FOV: 45 degrees, 2212x1672, retinal fundus photograph: 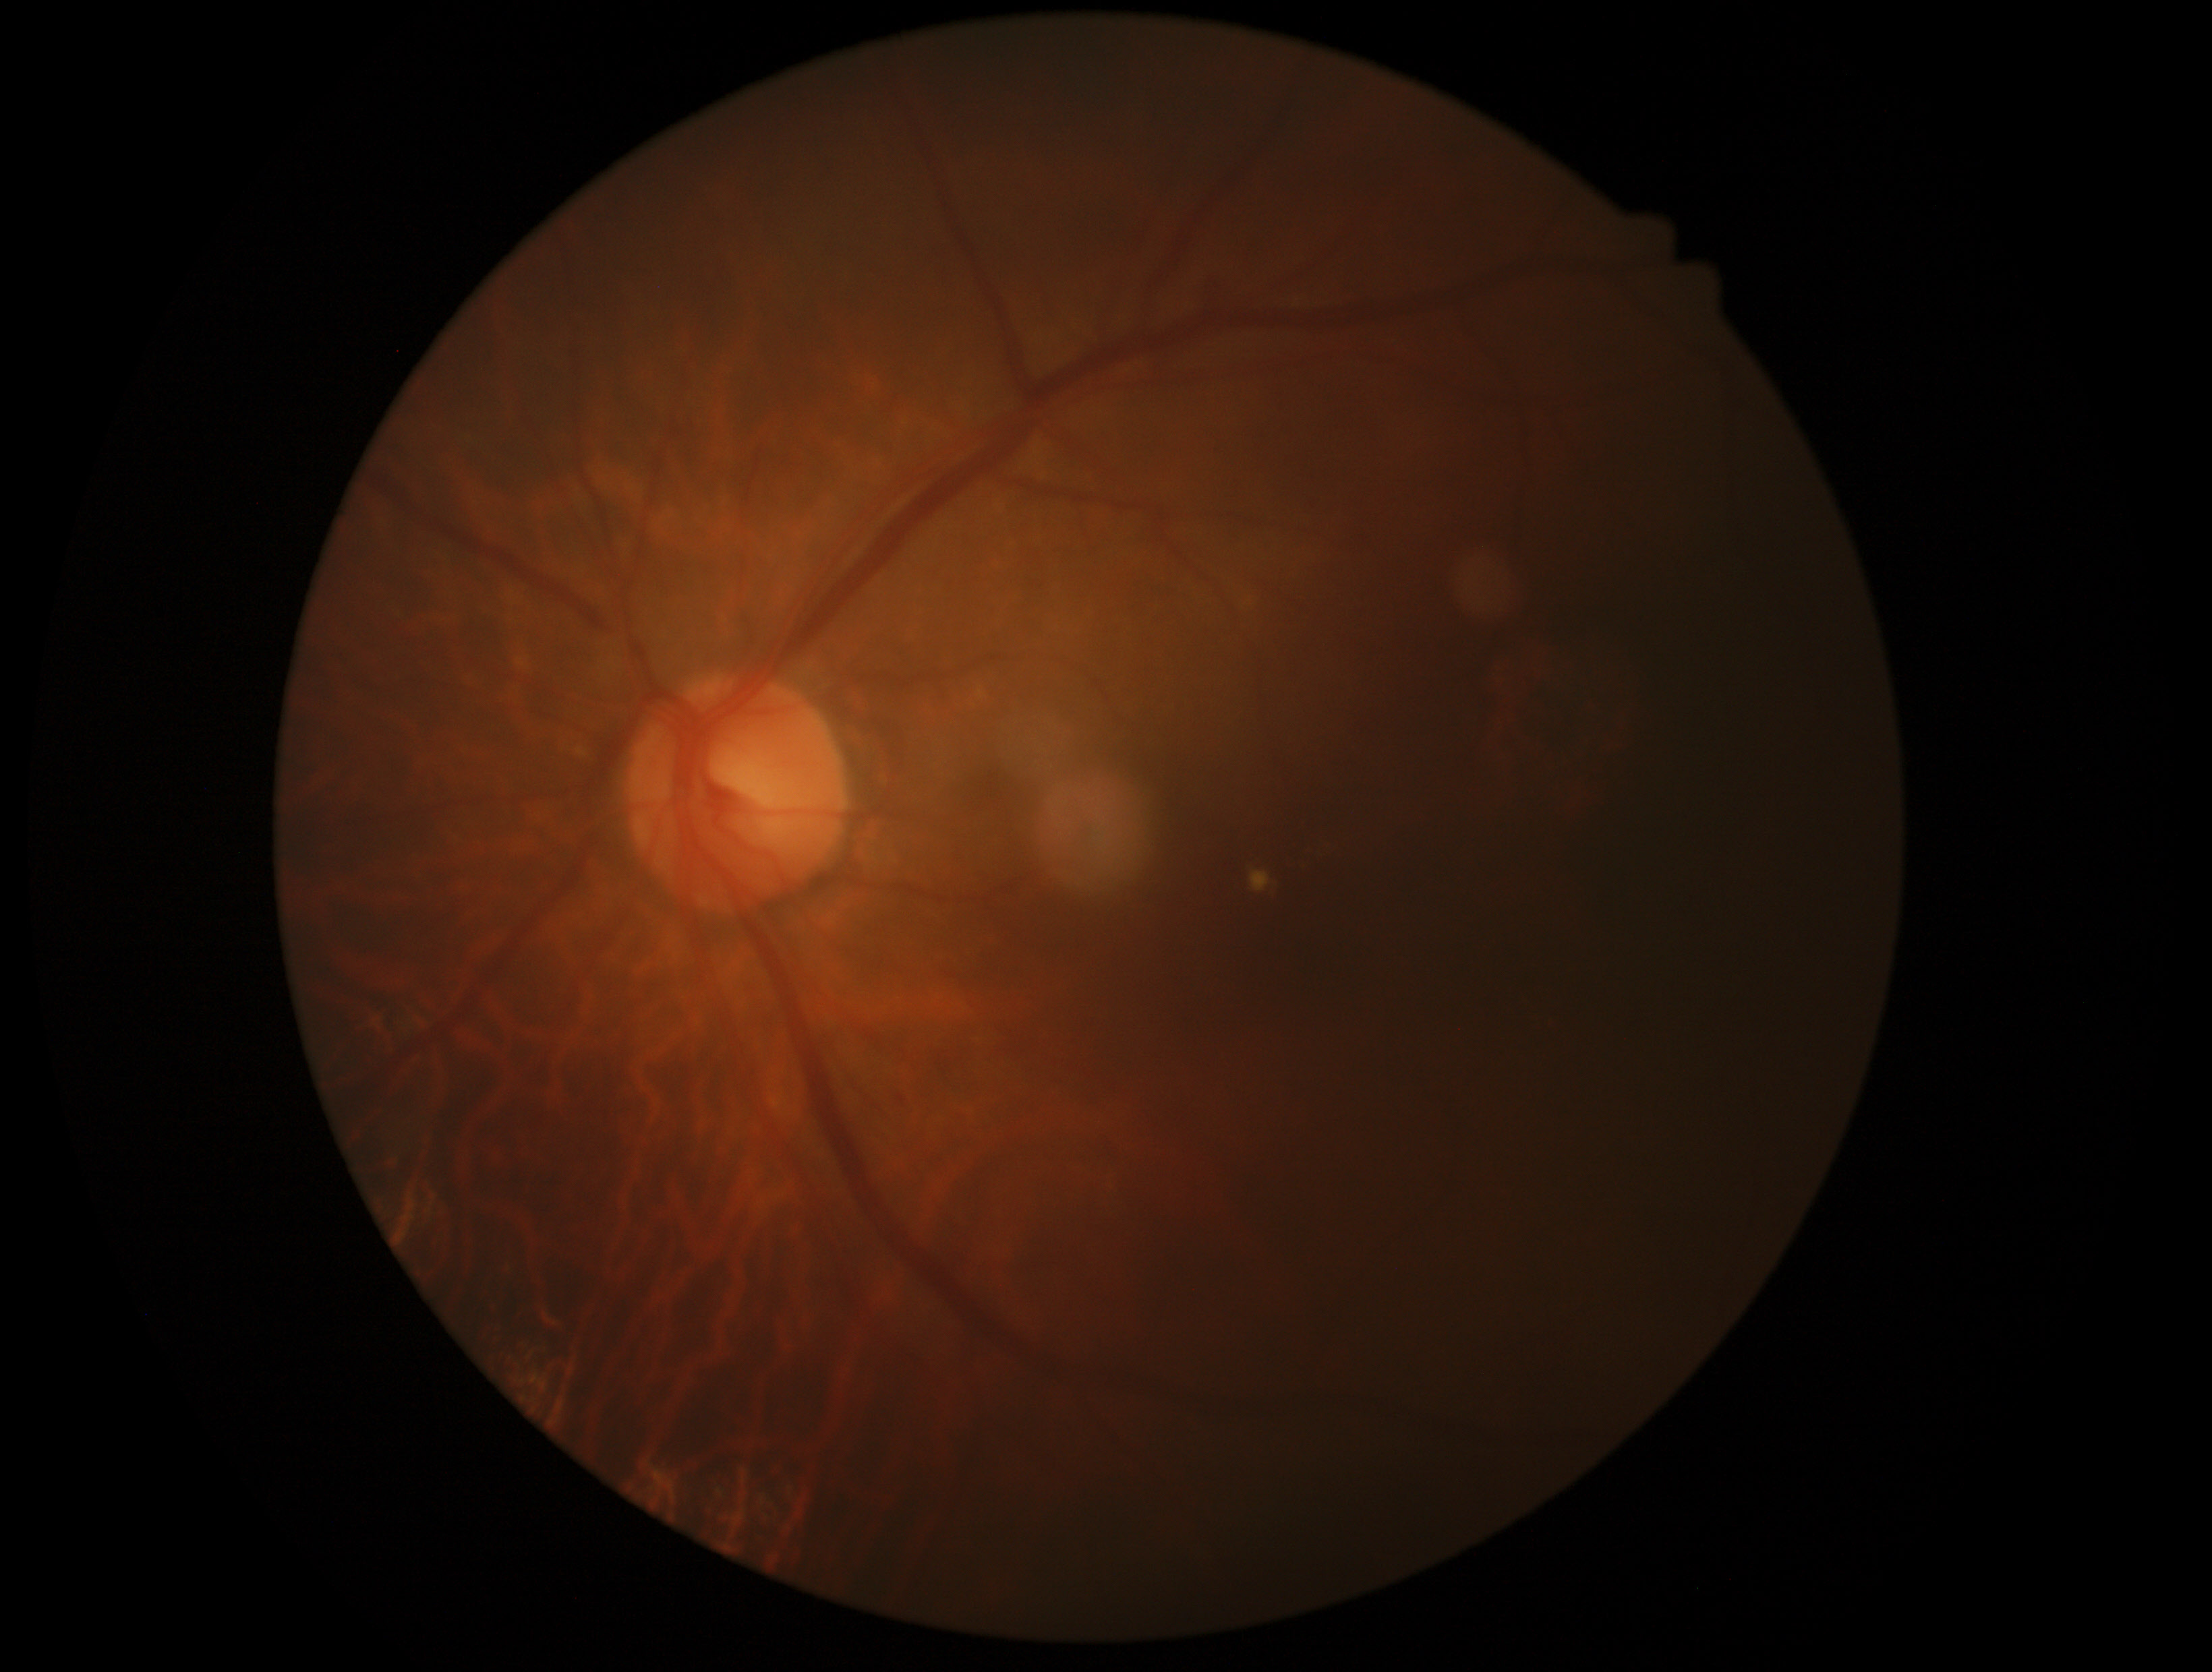 Retinopathy grade is 2 (moderate NPDR) — more than just microaneurysms but less than severe NPDR.